Davis DR grading, no pharmacologic dilation:
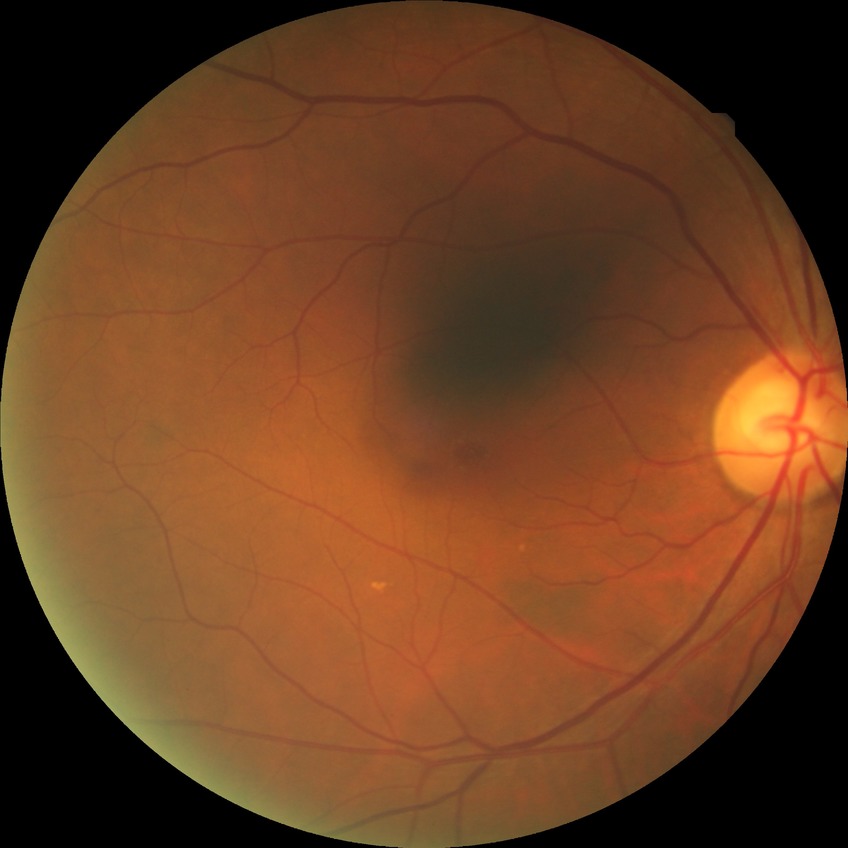
diabetic retinopathy stage@no diabetic retinopathy.